Infant wide-field fundus photograph. 130° field of view (Clarity RetCam 3) — 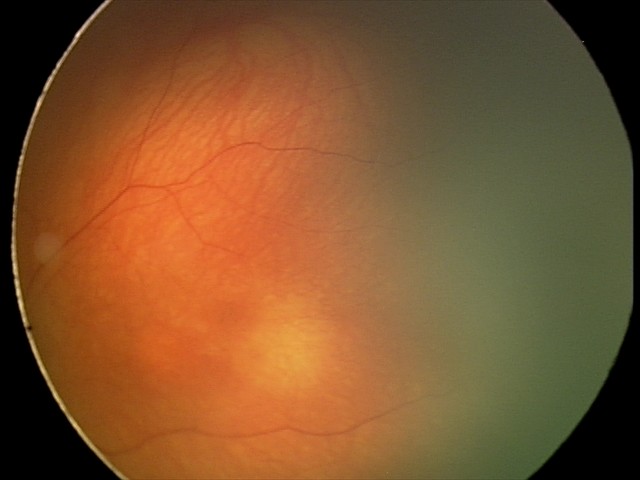
Normal screening examination.